Optic disc region crop.
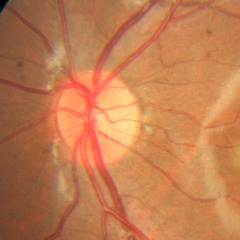
Findings consistent with no glaucomatous optic neuropathy.